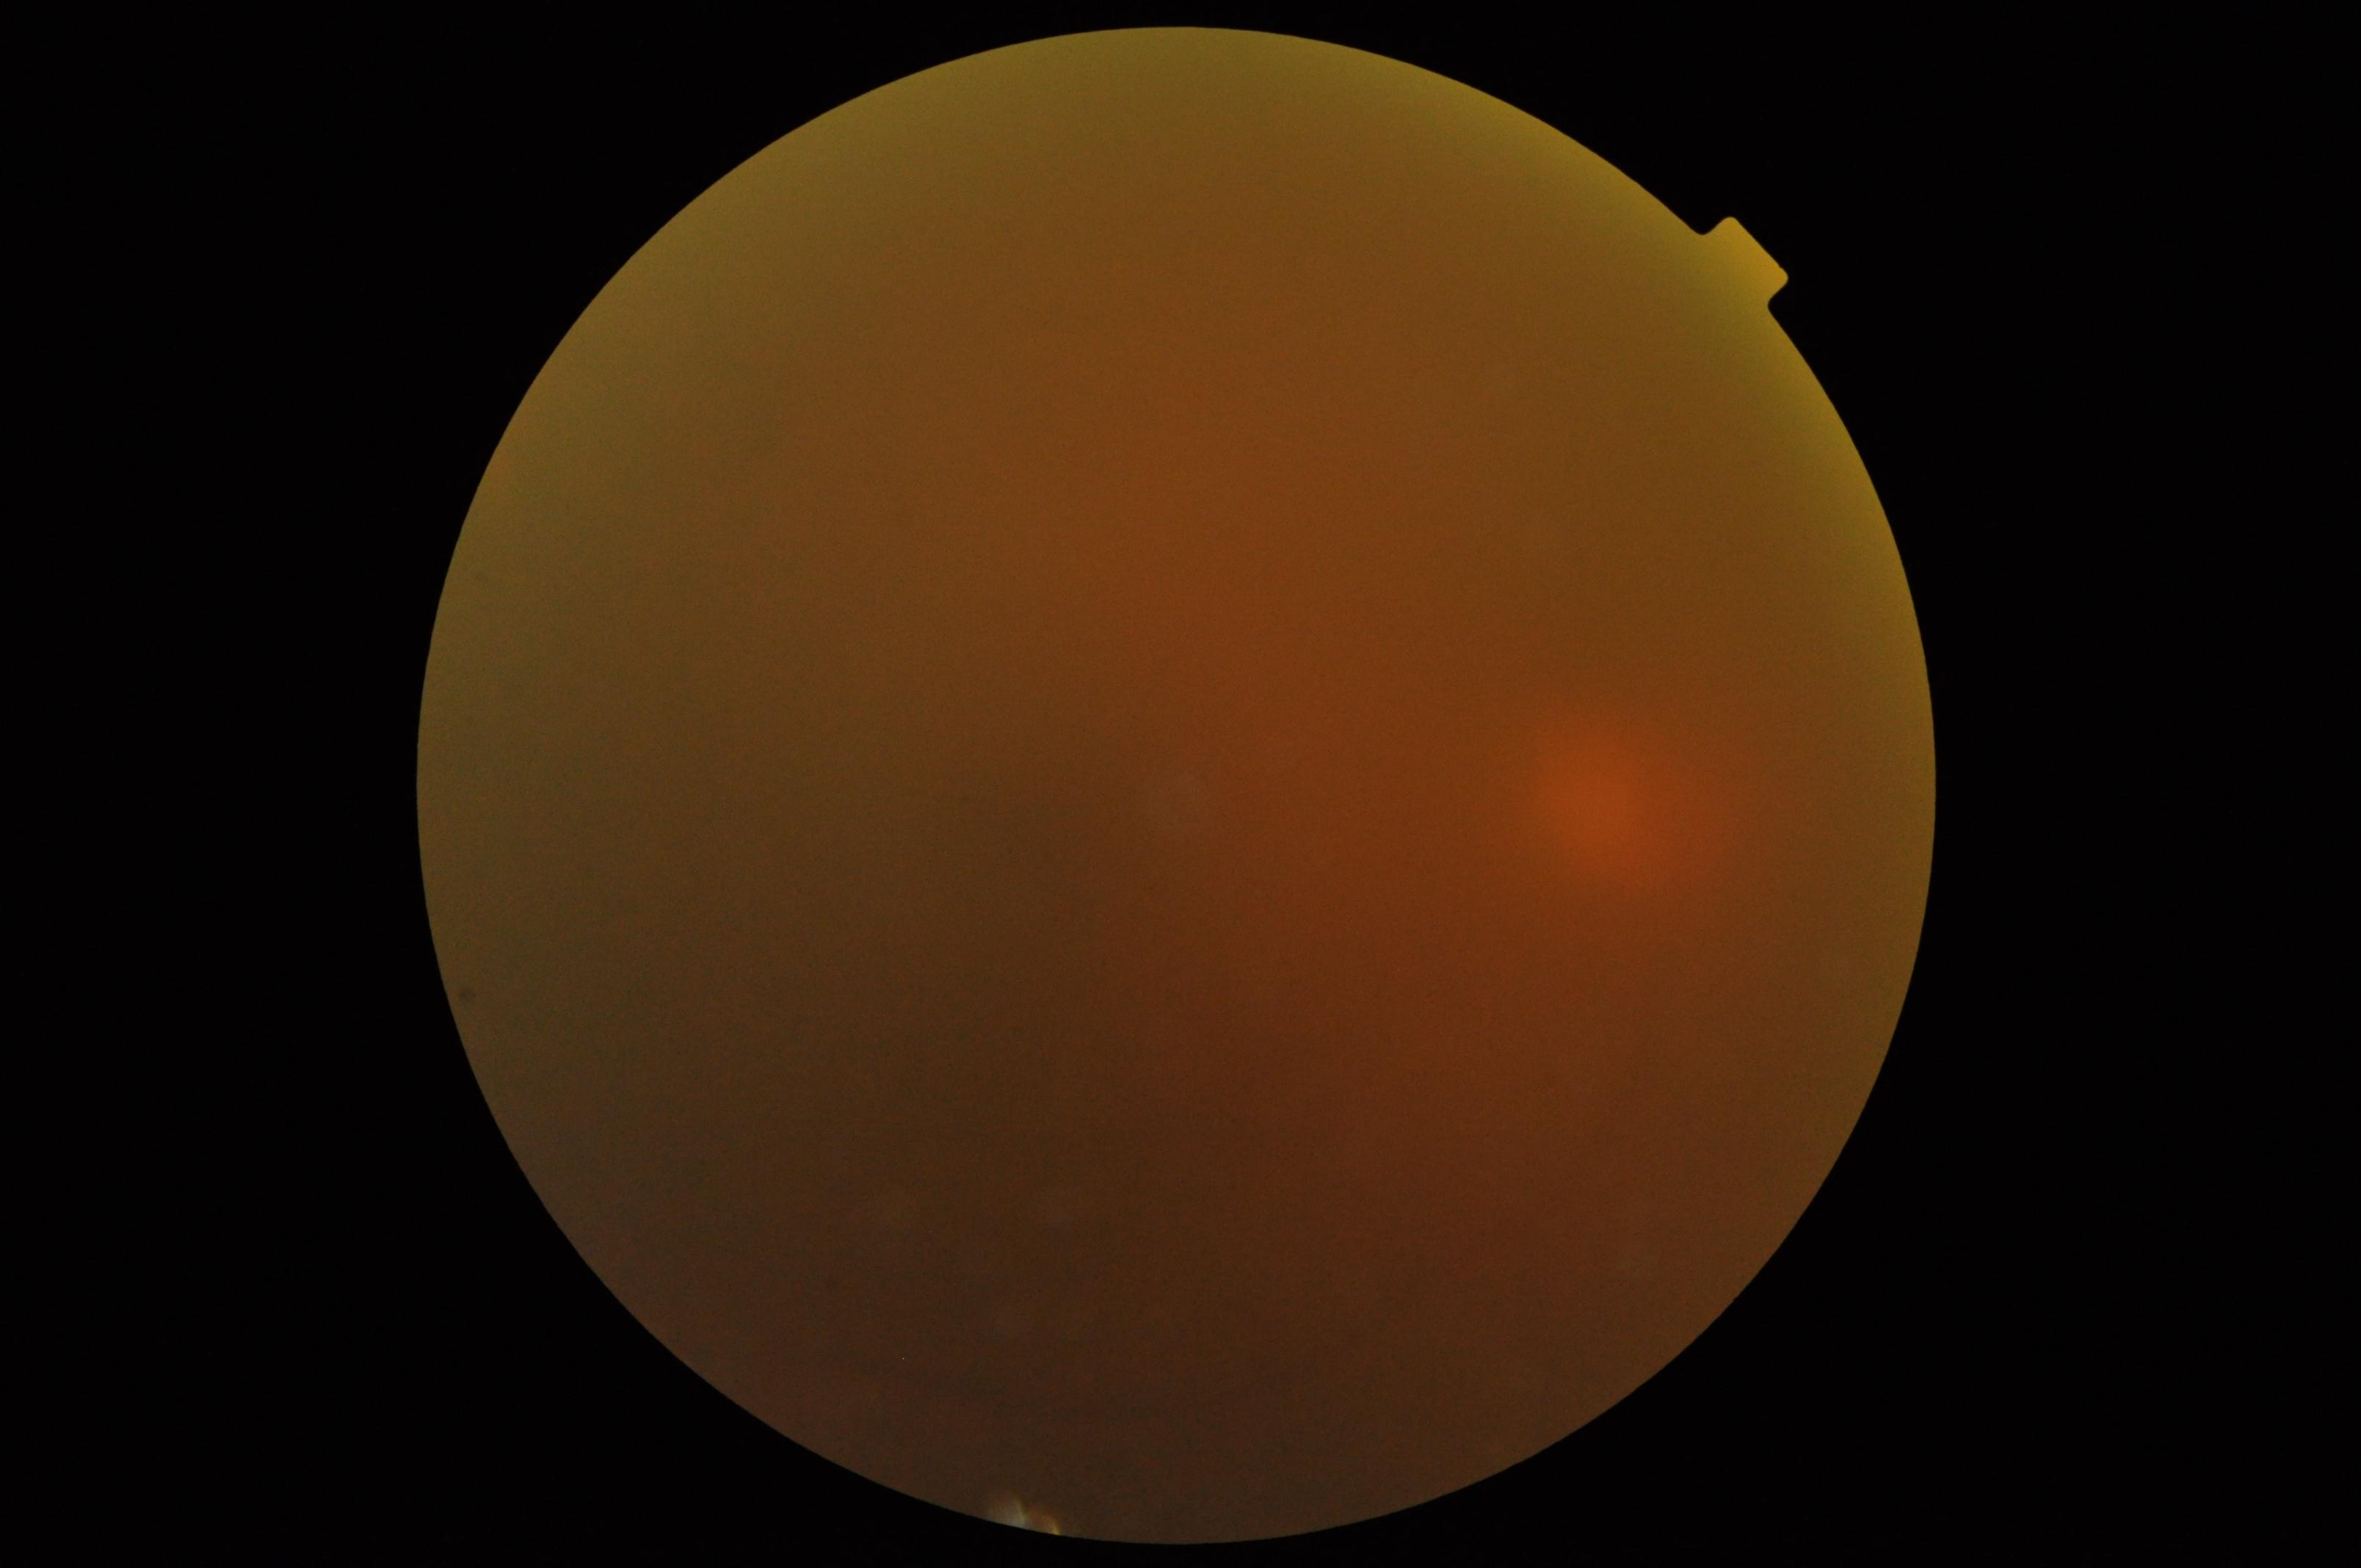
diabetic retinopathy (DR)=ungradable, image quality=too poor for DR grading.